Color fundus image · nonmydriatic · image size 848x848 · DR severity per modified Davis staging
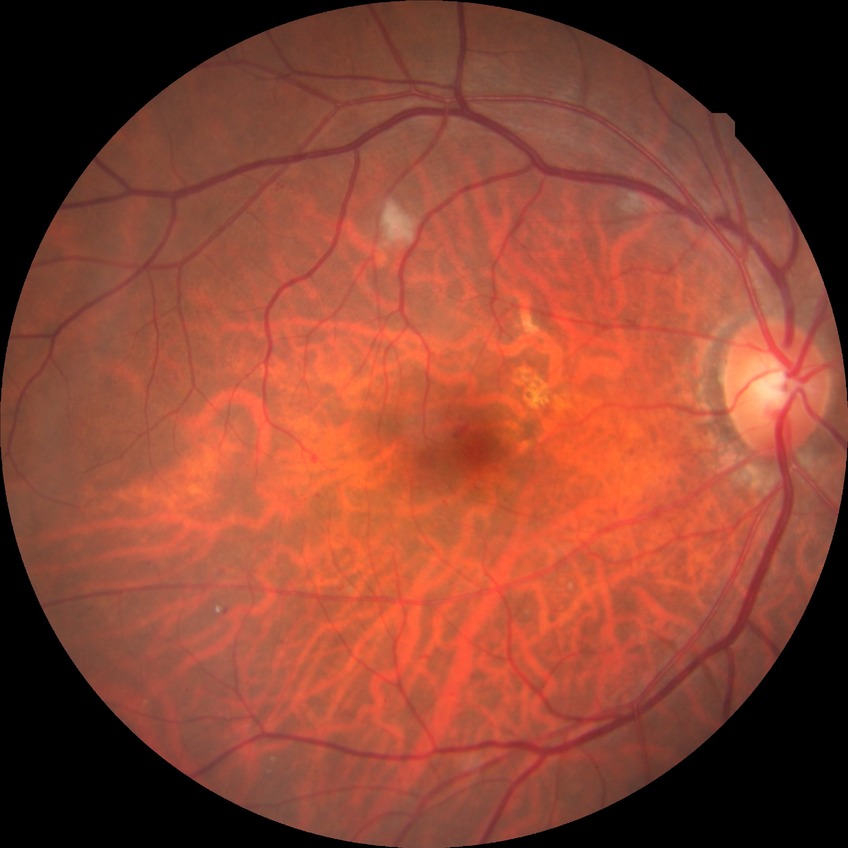 Findings:
- diabetic retinopathy (DR) — simple diabetic retinopathy (SDR)